DR severity per modified Davis staging — 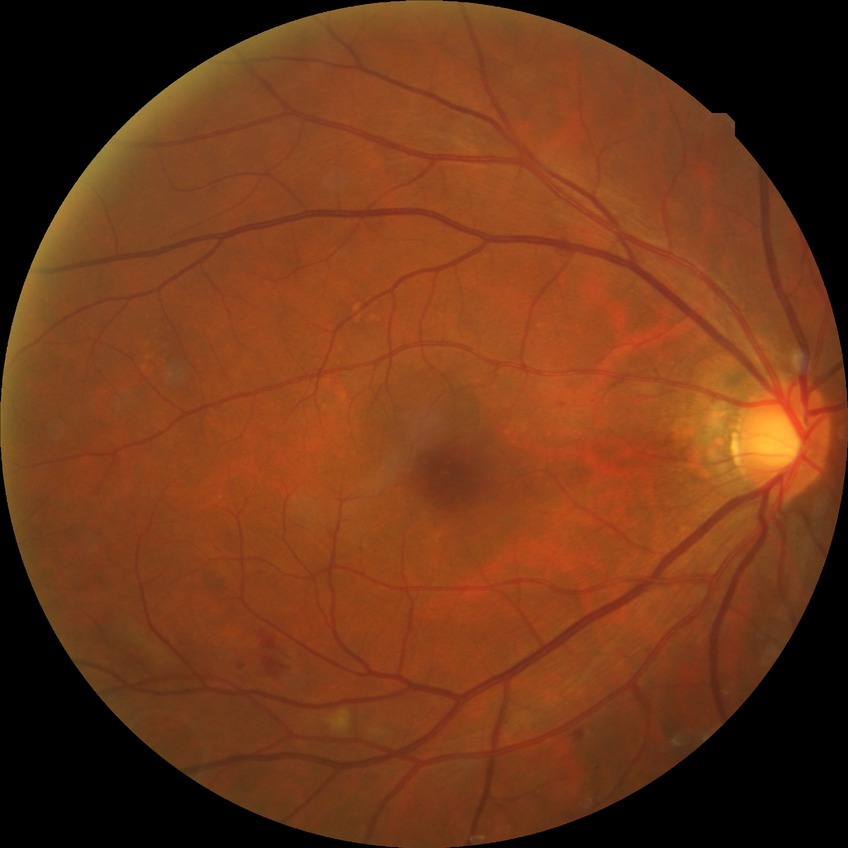
  proliferative_class: non-proliferative diabetic retinopathy
  davis_grade: SDR